Image size 2212x1659.
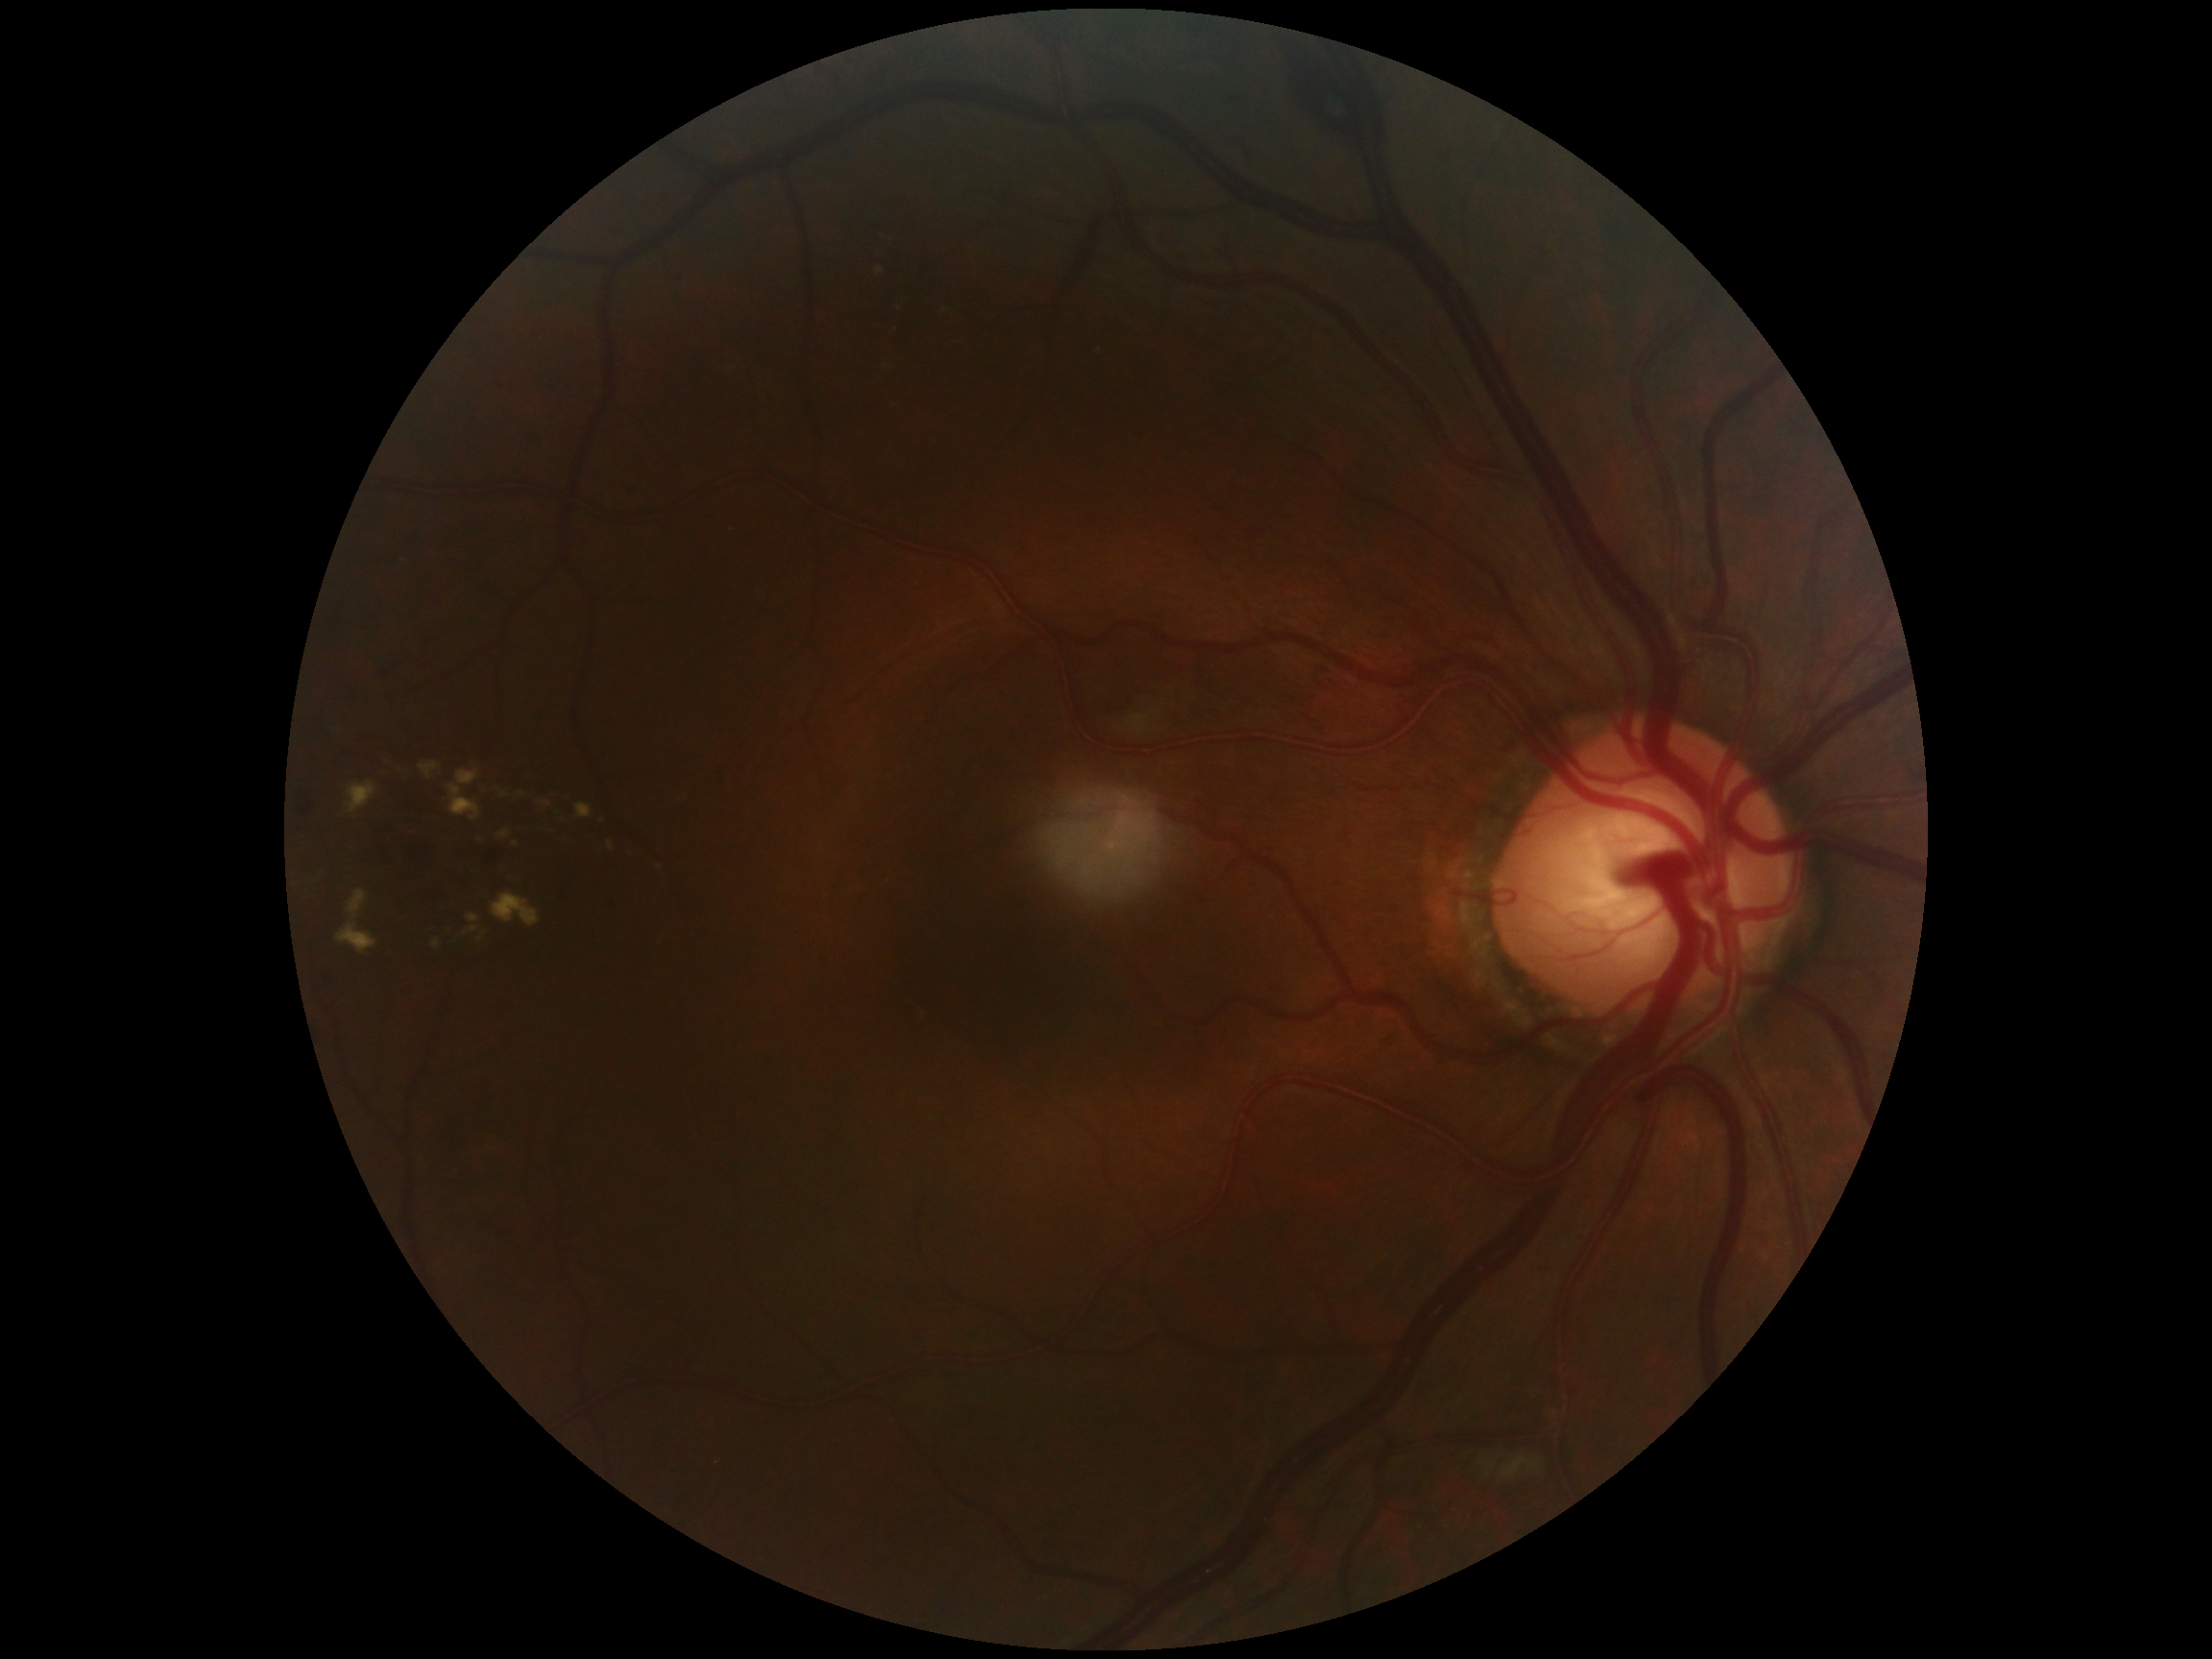
DR is grade 2 (moderate NPDR).